Pediatric retinal photograph (wide-field): 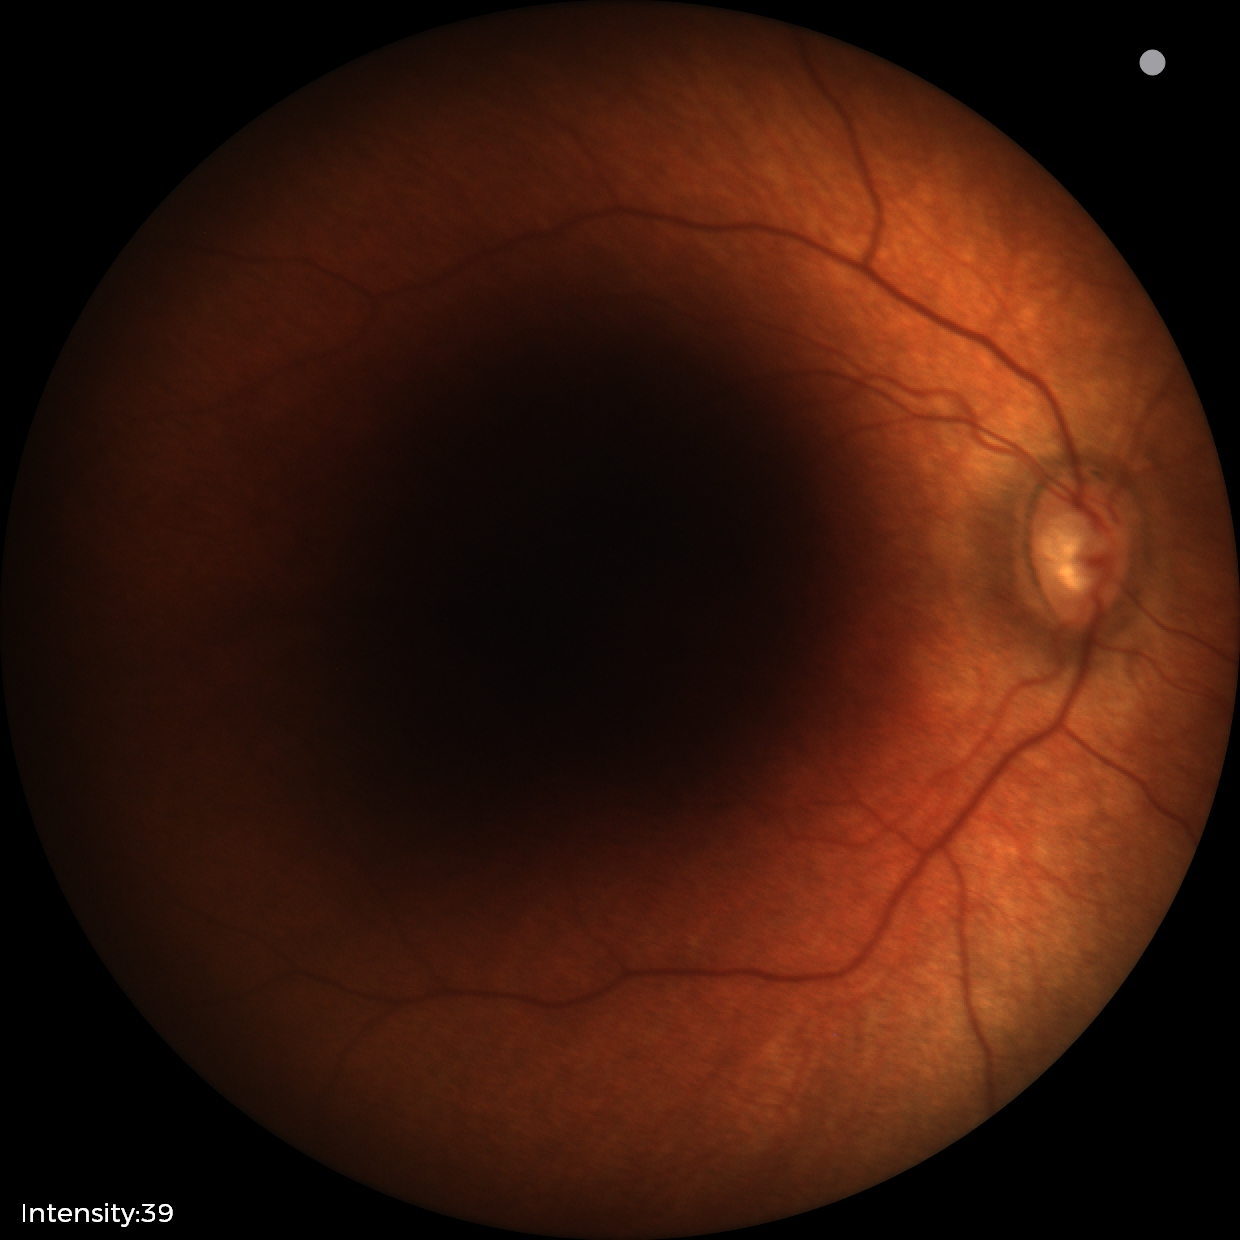 No retinal pathology identified on screening.